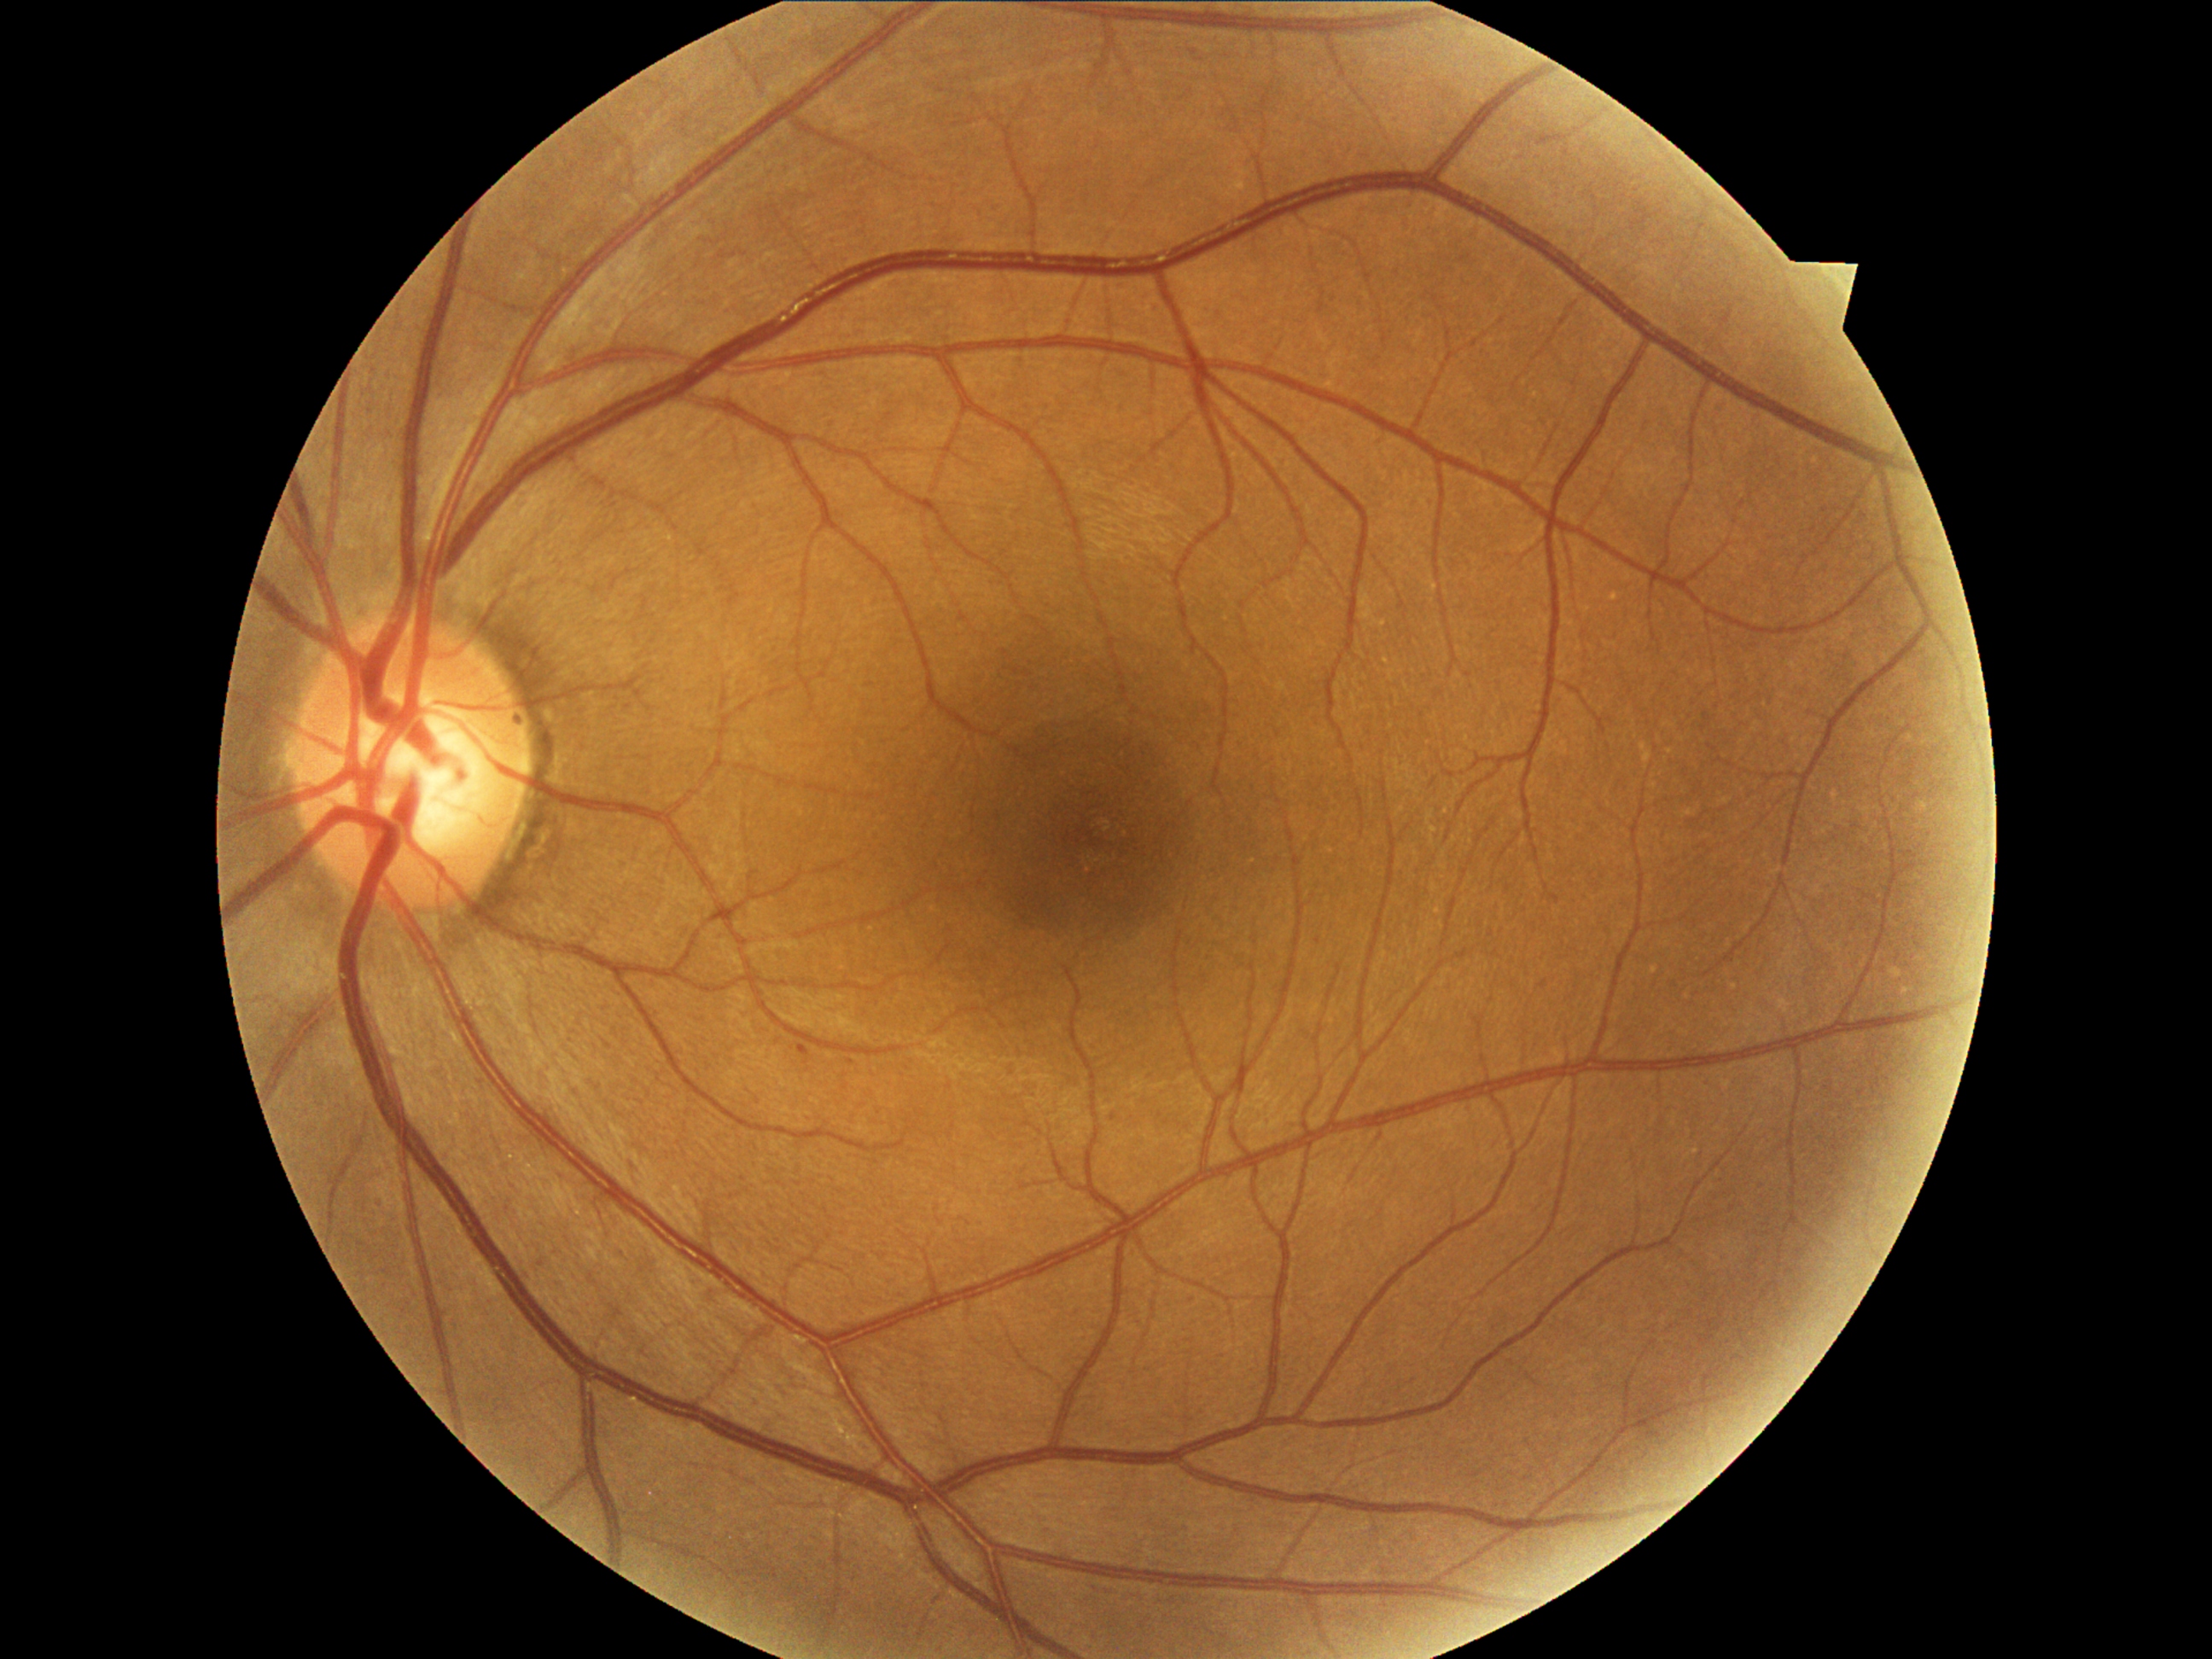
dr_grade: 1
dr_grade_name: mild NPDR
lesions:
  ex: []
  he: []
  ma:
    - x1=798 y1=1045 x2=810 y2=1057
    - x1=847 y1=1059 x2=856 y2=1066
    - x1=1551 y1=895 x2=1561 y2=904
  ma_small_centers:
    - <pt>1115,1119</pt>
  se: []